Color fundus photograph, 2212x1659px, FOV: 45 degrees: 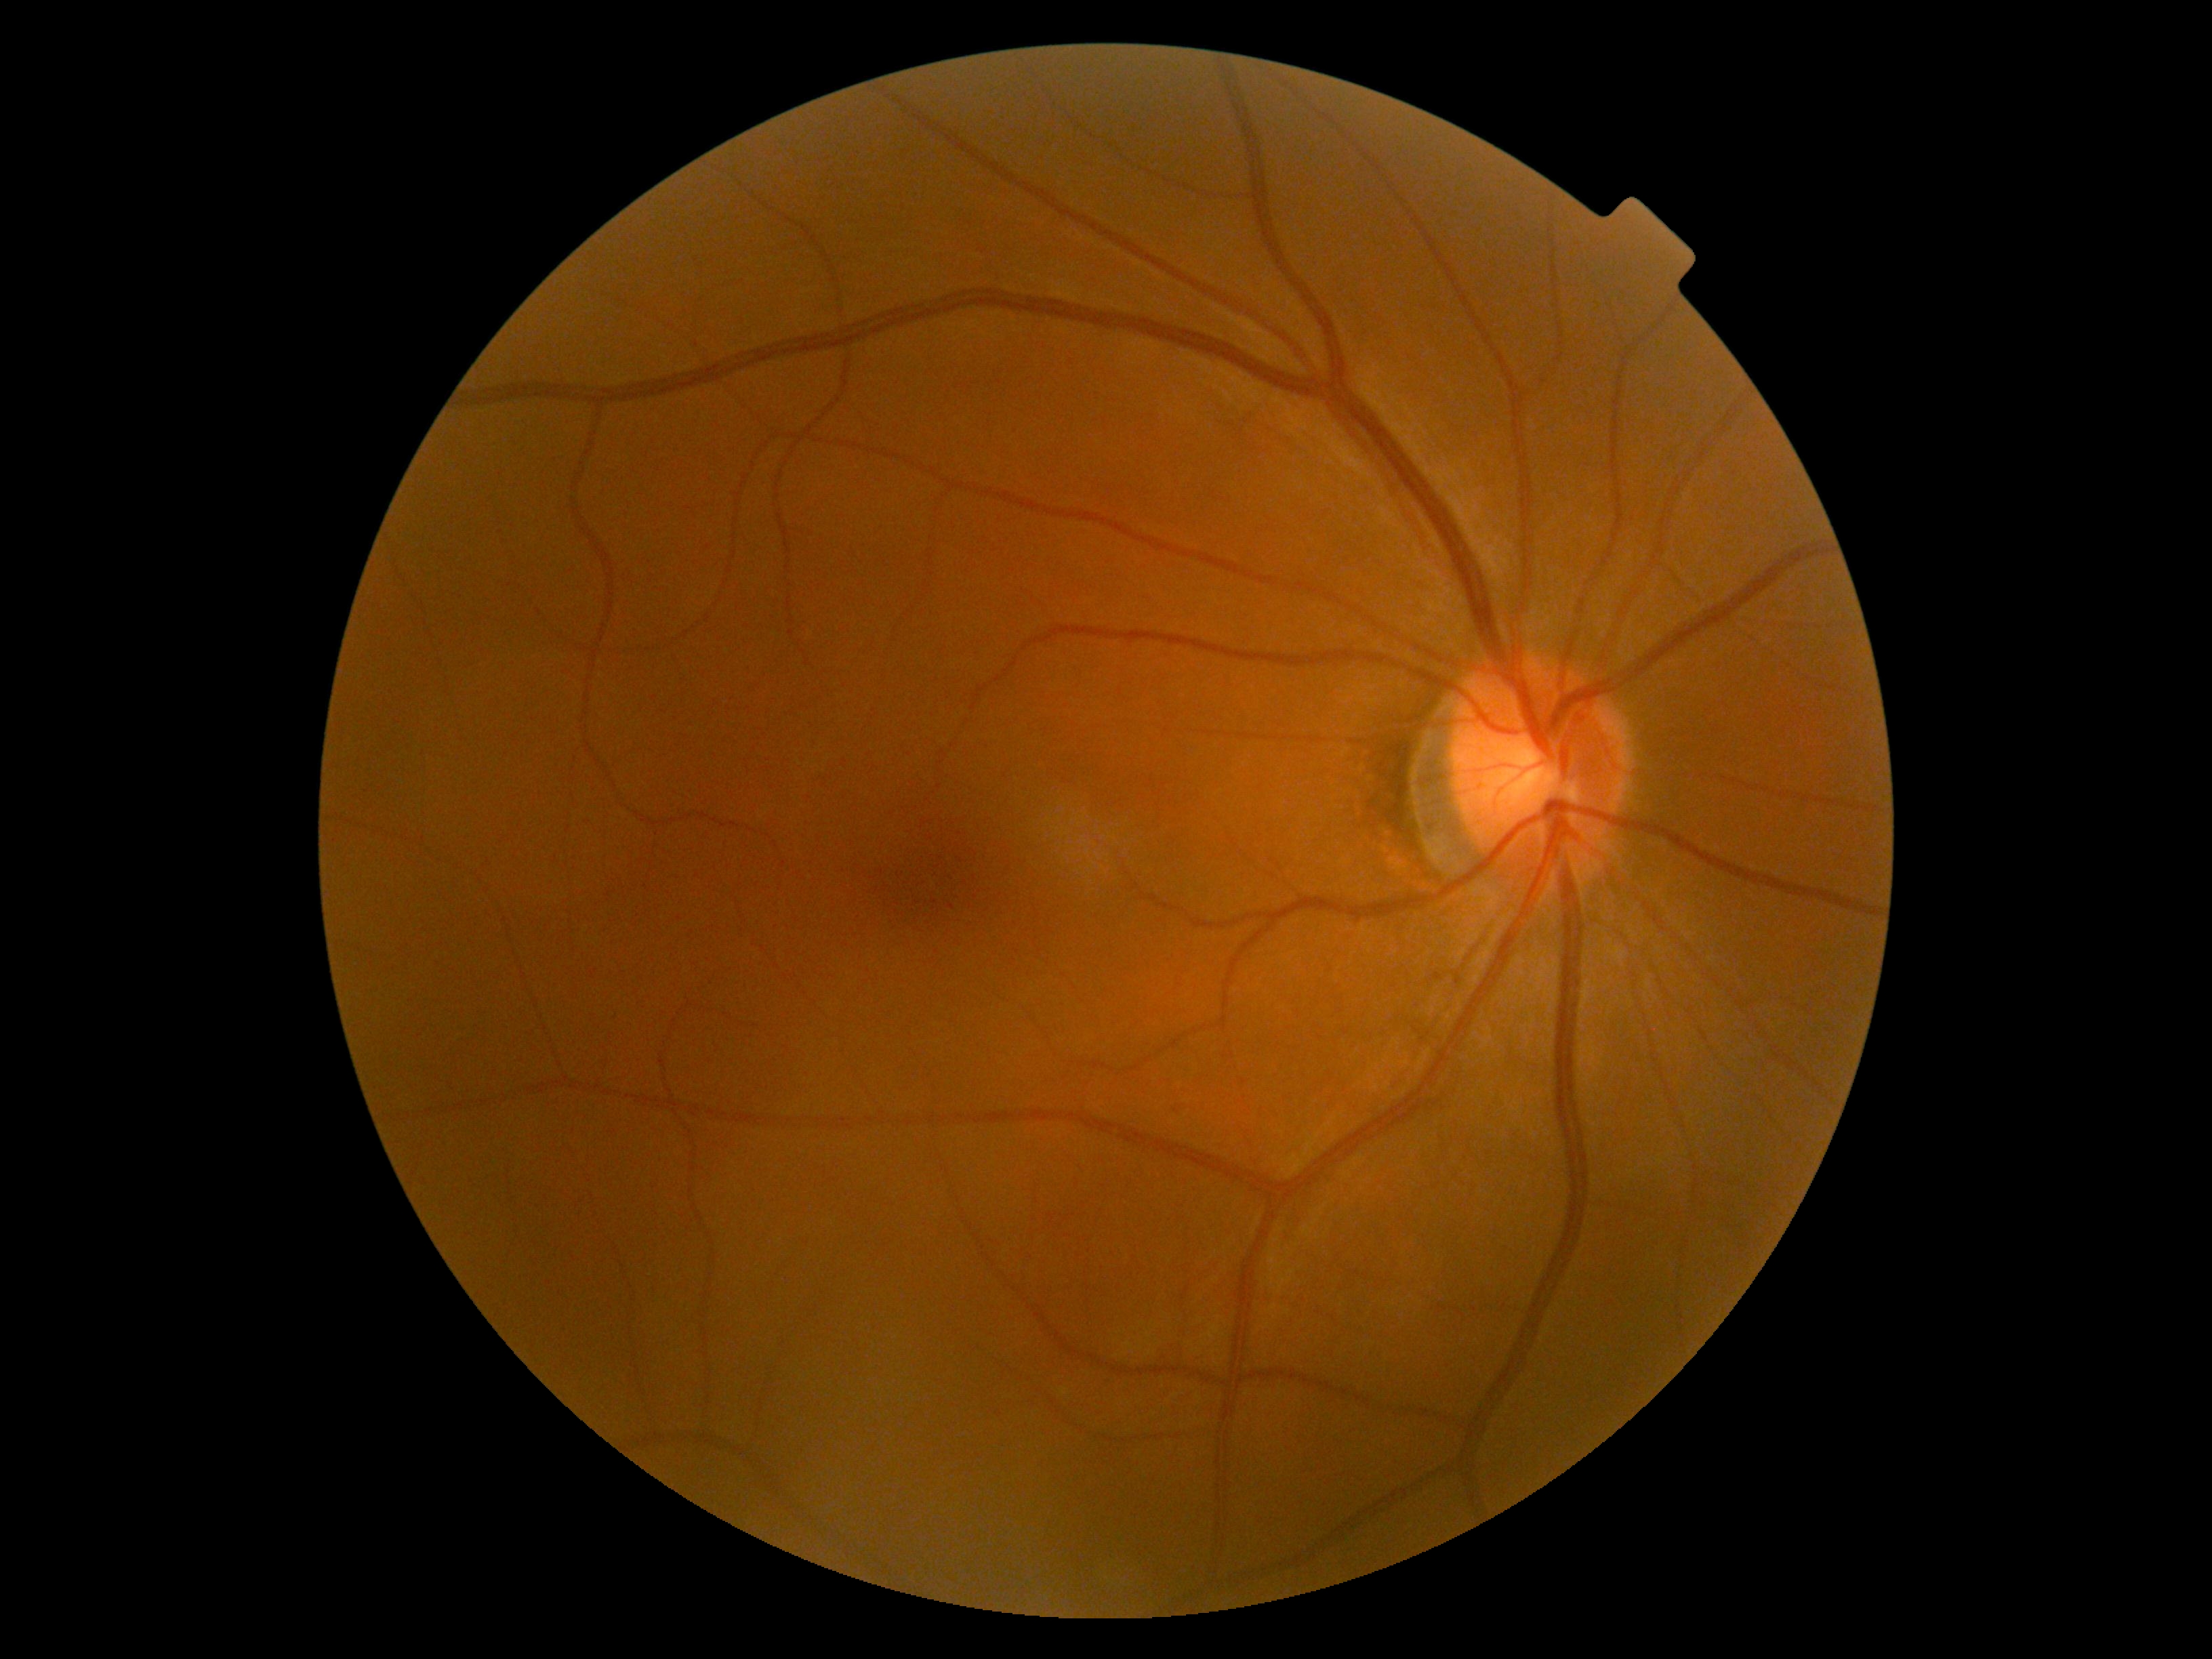
- DR impression: negative for DR
- diabetic retinopathy (DR): grade 0 (no apparent retinopathy)